848x848 · 45° FOV: 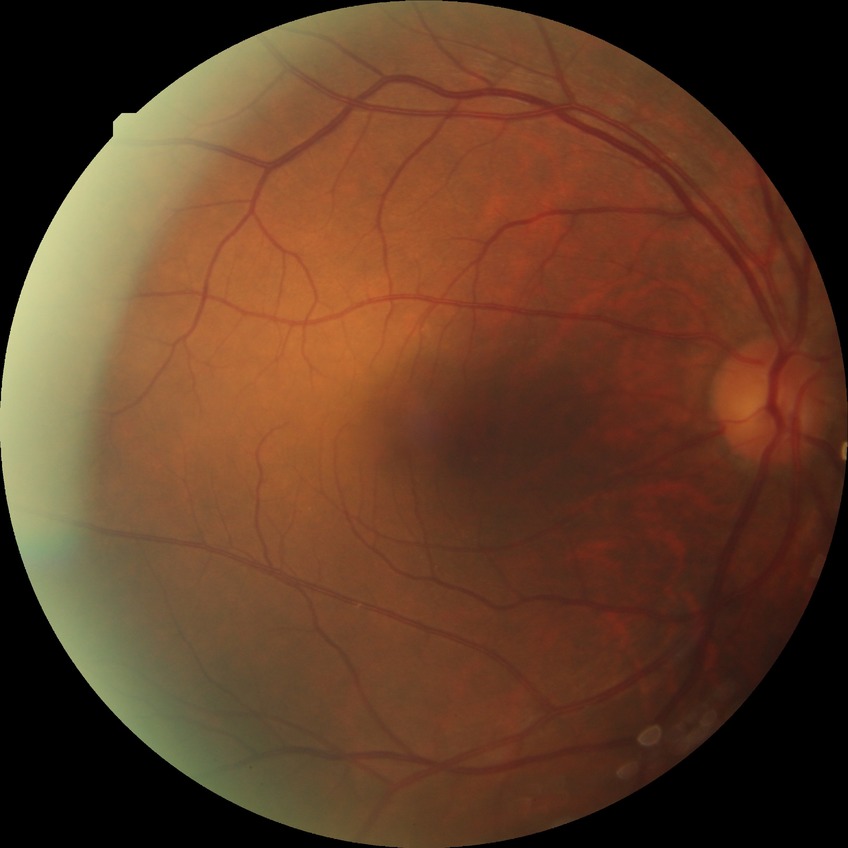 retinopathy stage = simple diabetic retinopathy